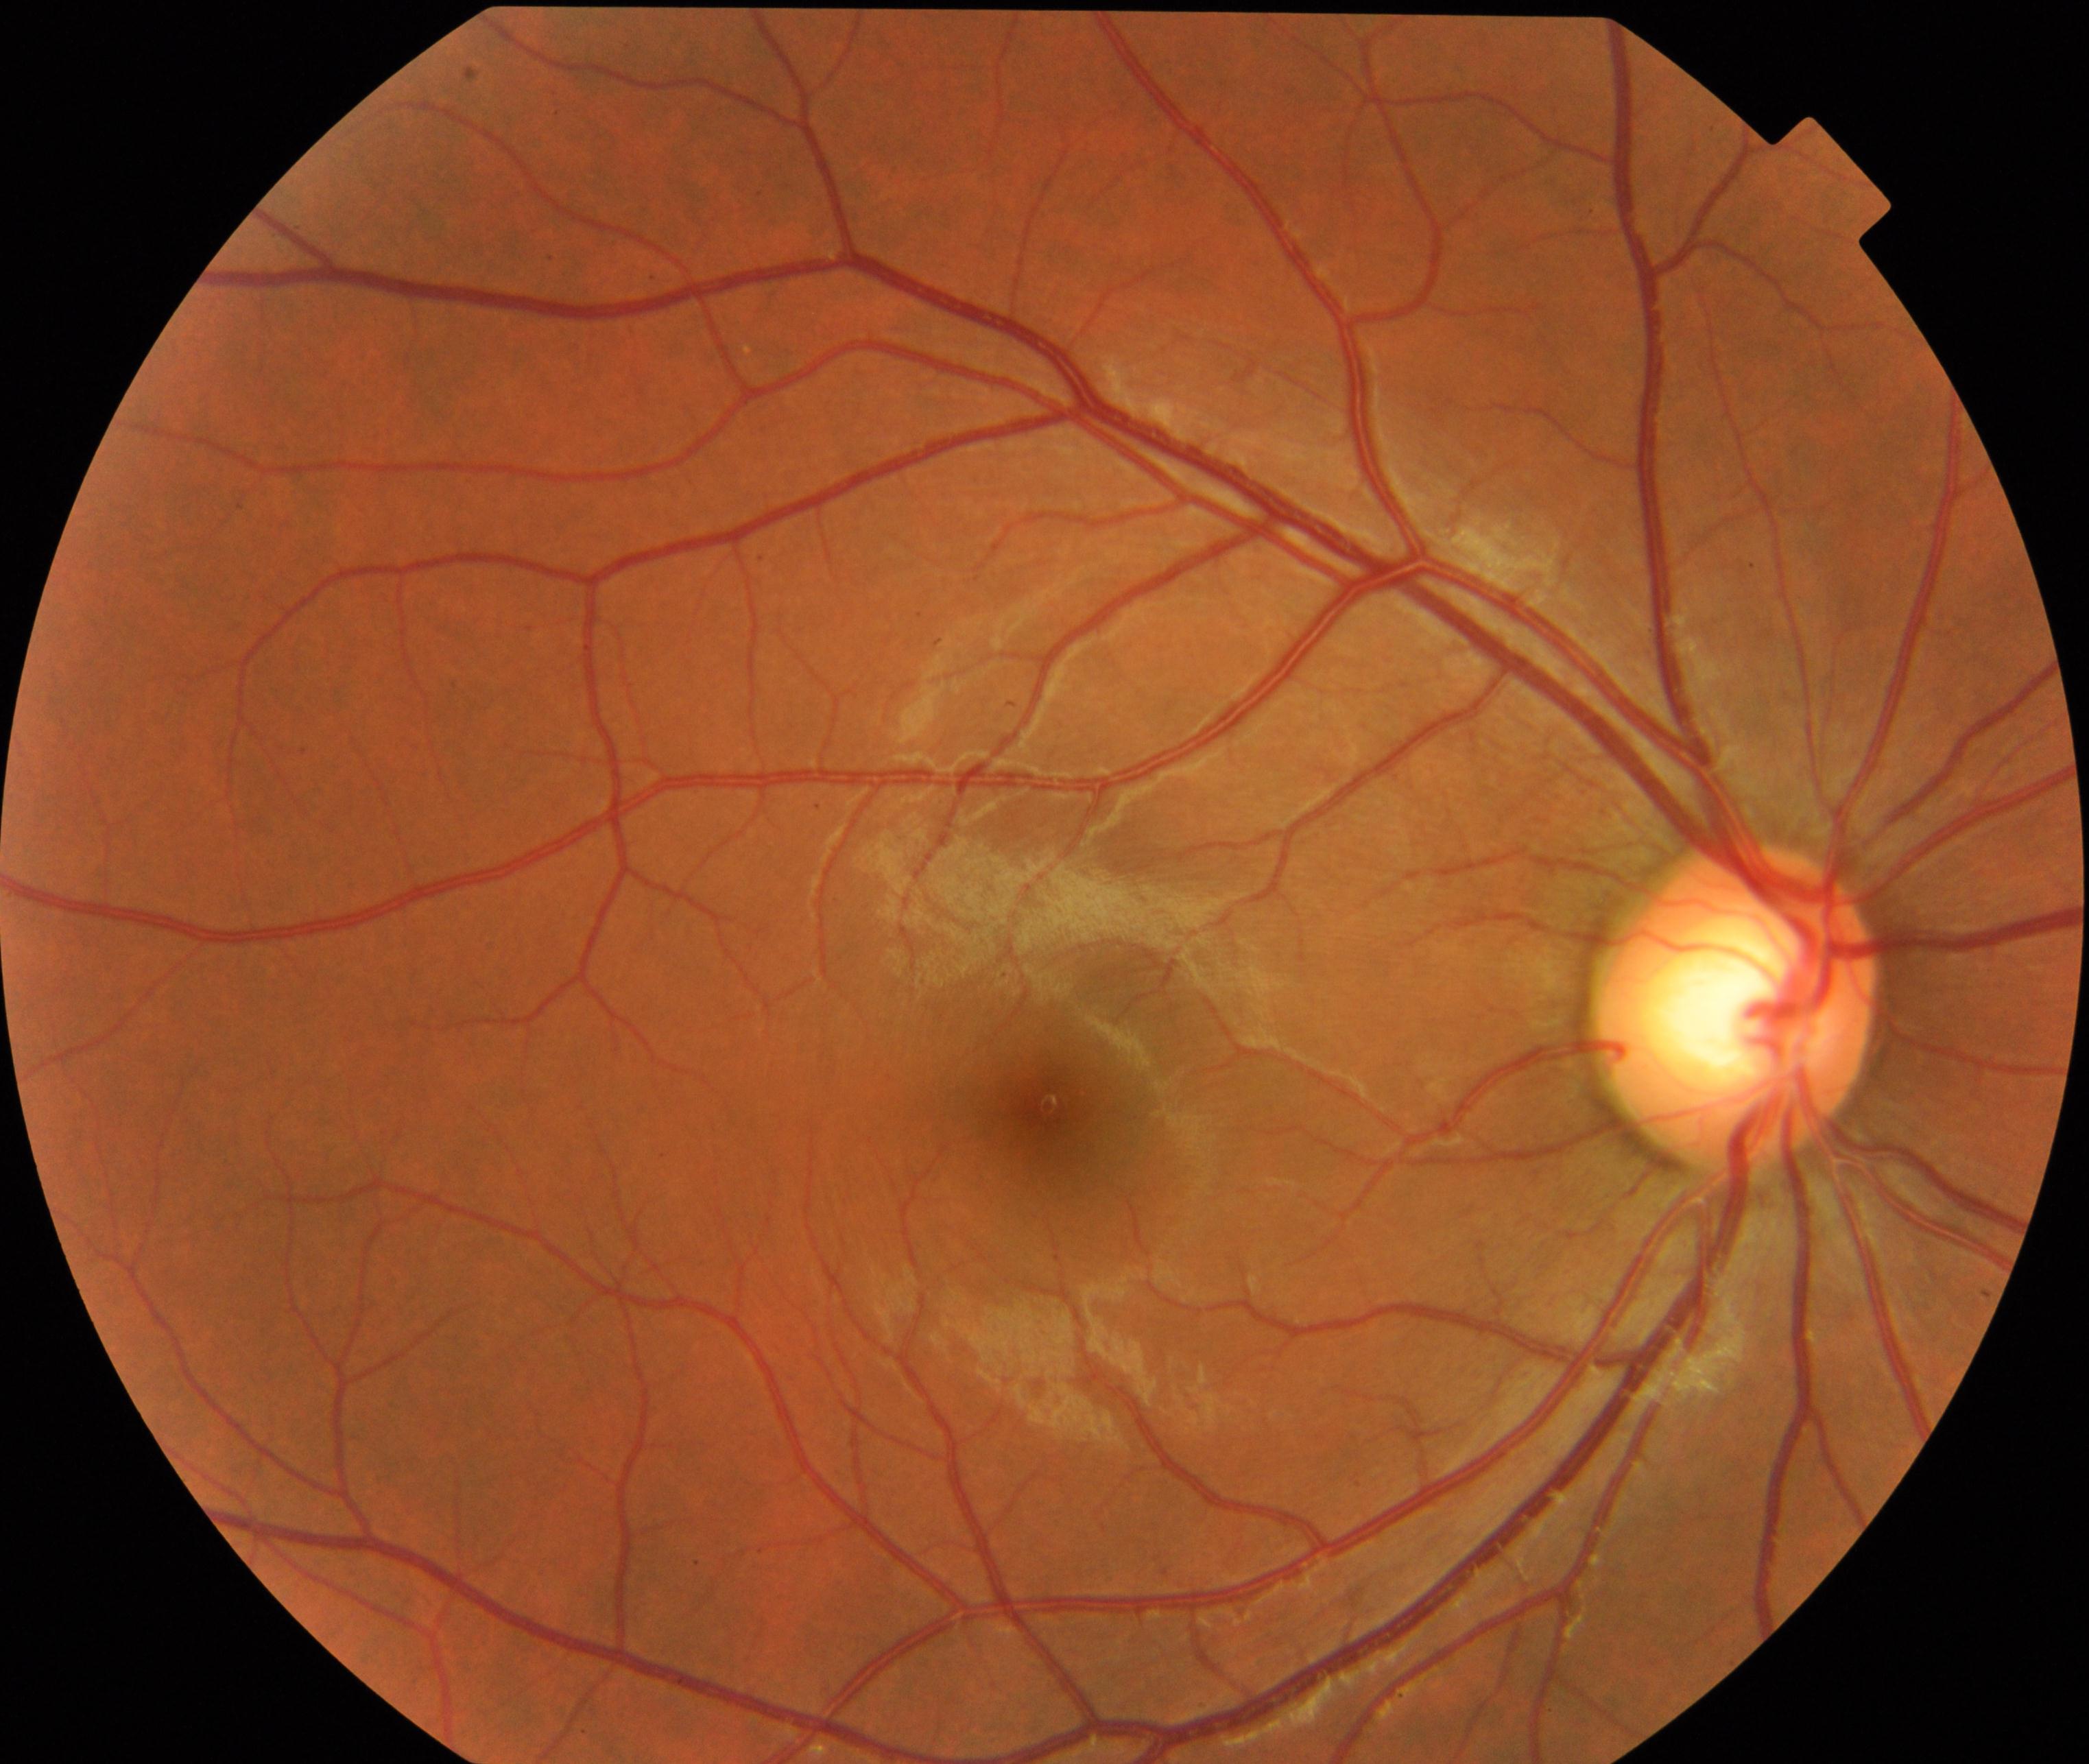
Diagnosis: large optic cup.